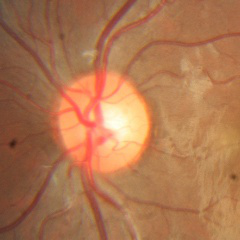
No signs of glaucoma.